Phoenix ICON, 100° FOV · pediatric retinal photograph (wide-field)
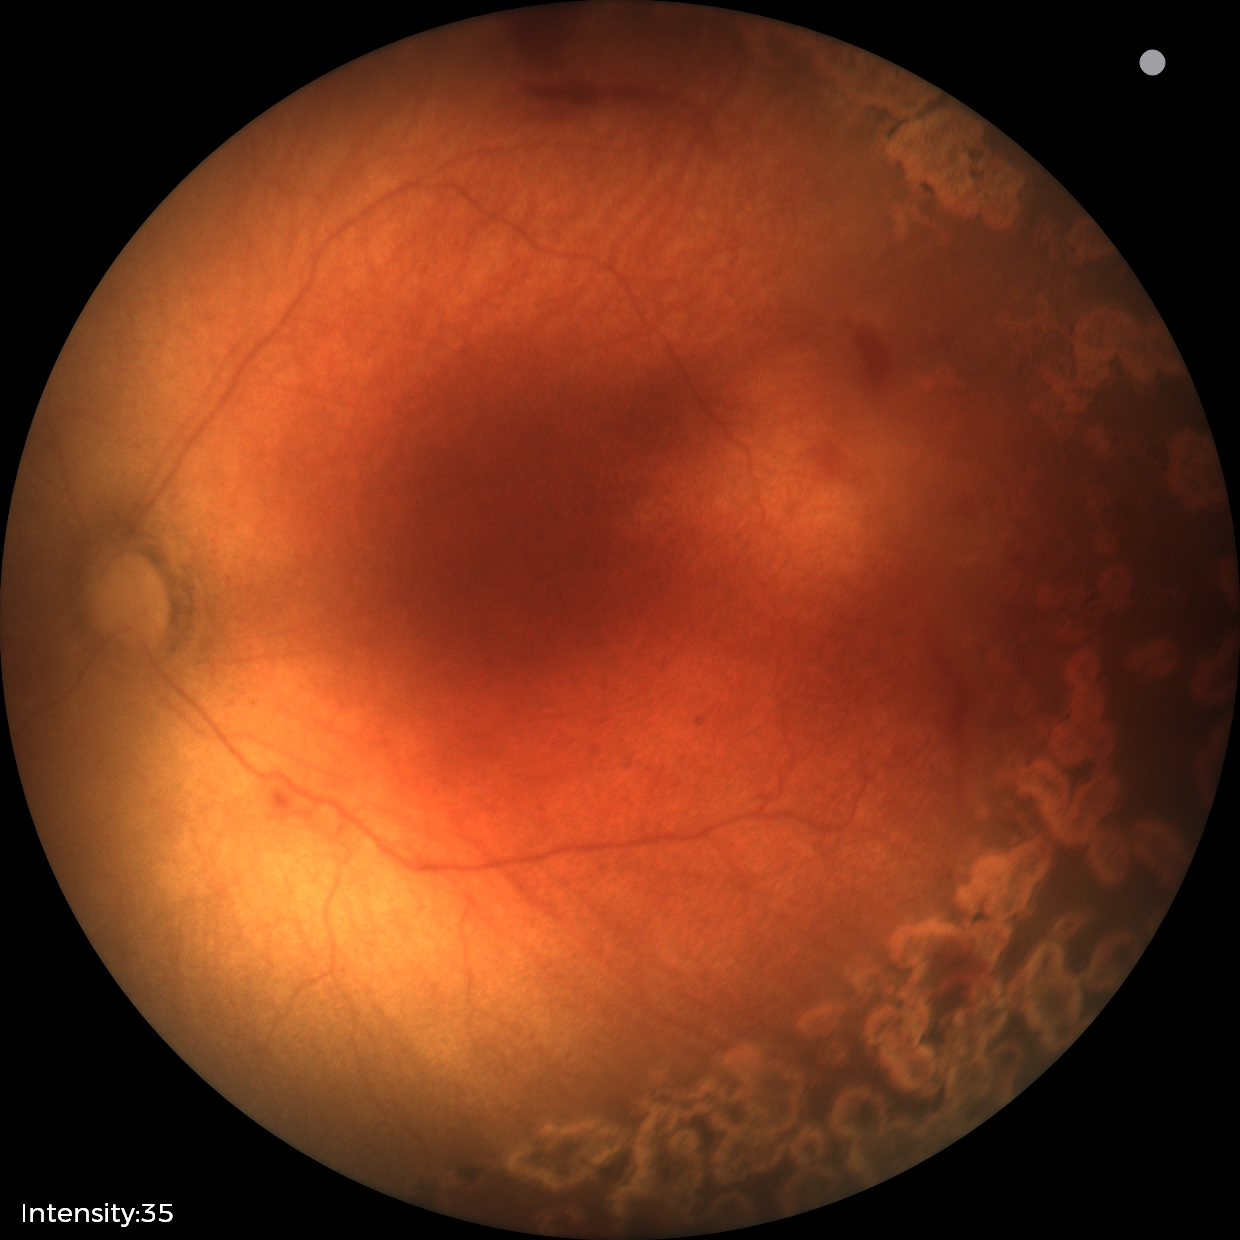

Plus disease absent.
Examination diagnosed as status post retinopathy of prematurity (ROP) — retinal appearance after treated retinopathy of prematurity.